Color fundus photograph centered on the optic disc
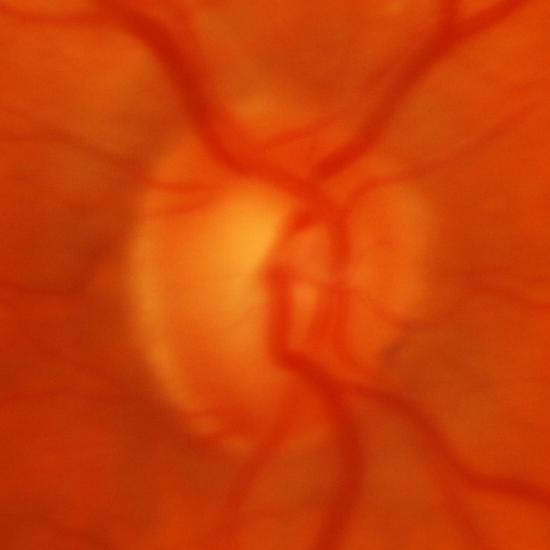 Q: Glaucoma assessment?
A: Yes — glaucoma.